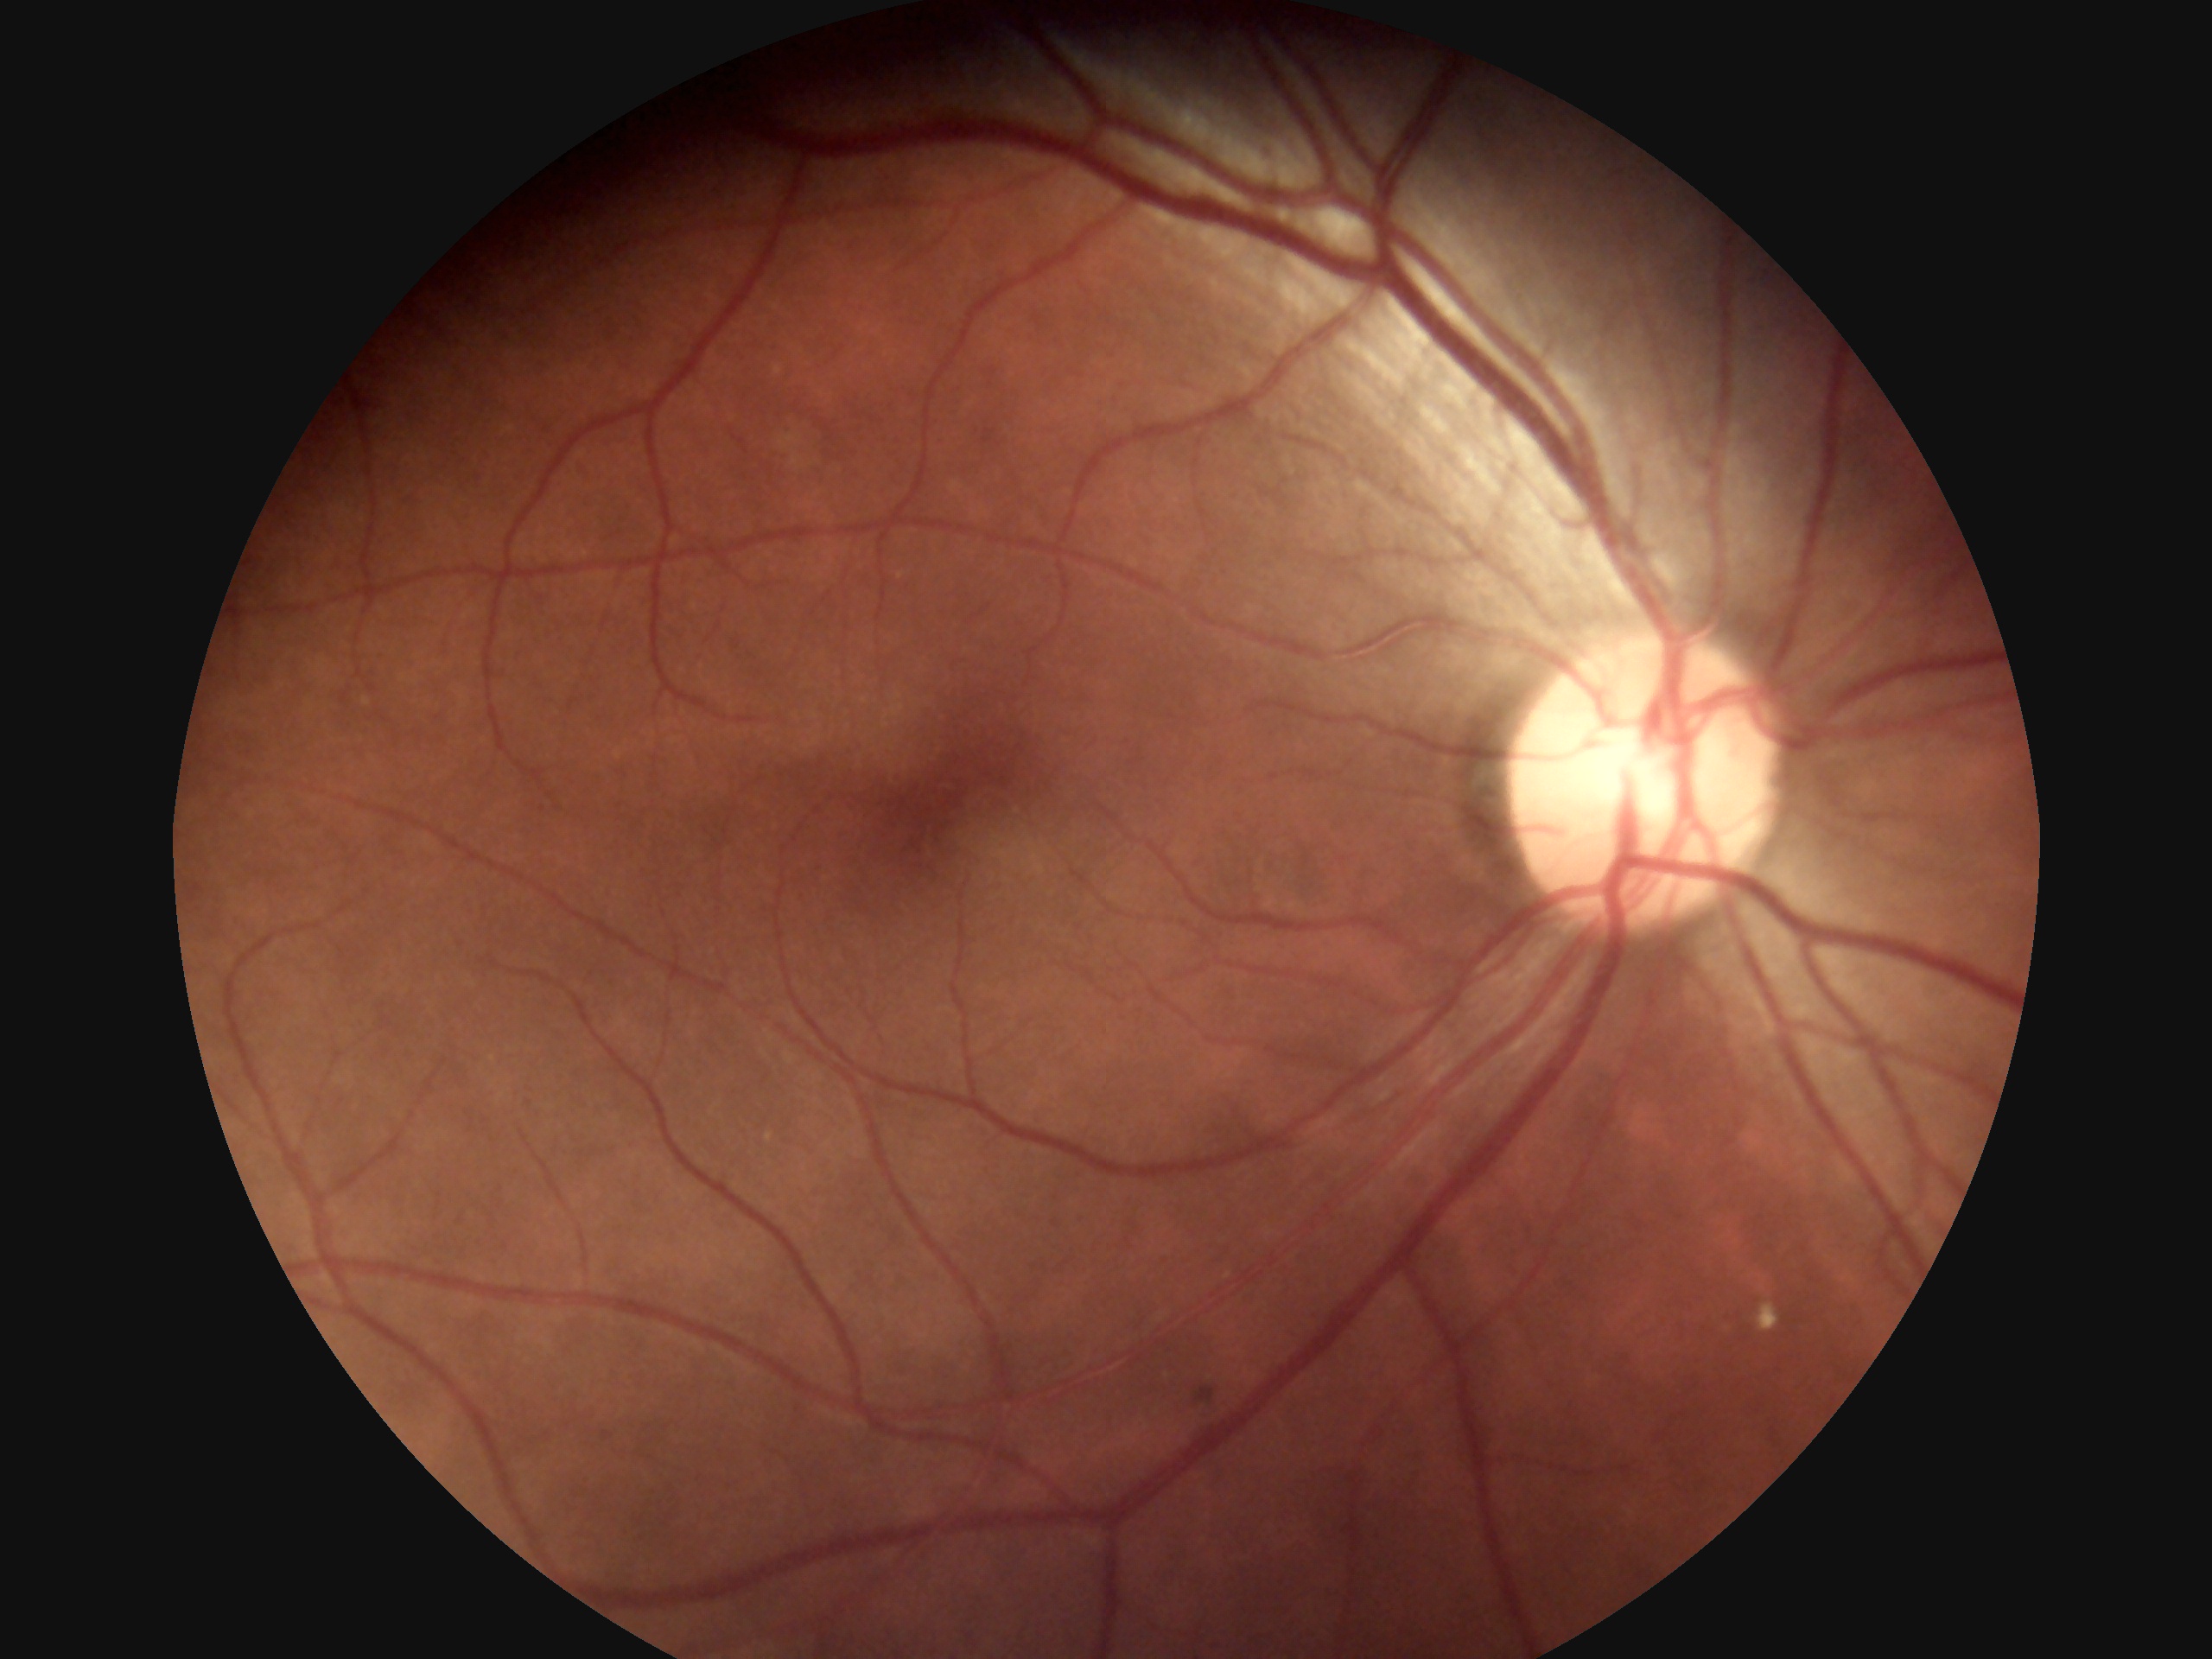 diabetic retinopathy severity=grade 2 (moderate NPDR).